45° field of view, modified Davis grading:
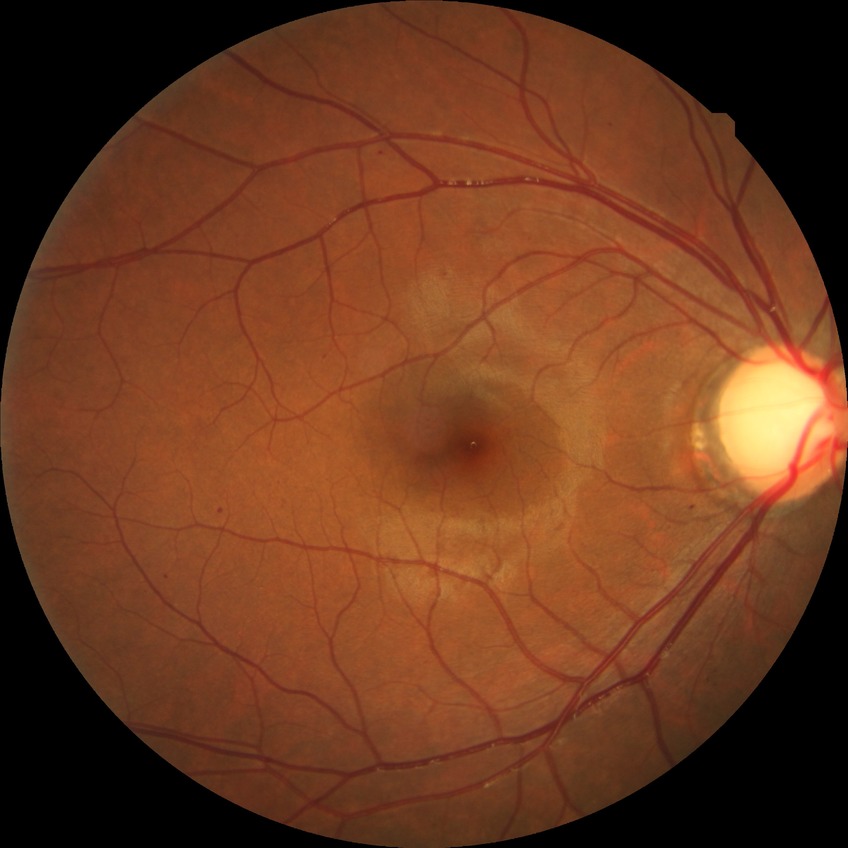

Annotations:
* Davis grading — simple diabetic retinopathy